2089x1764px; color fundus image:
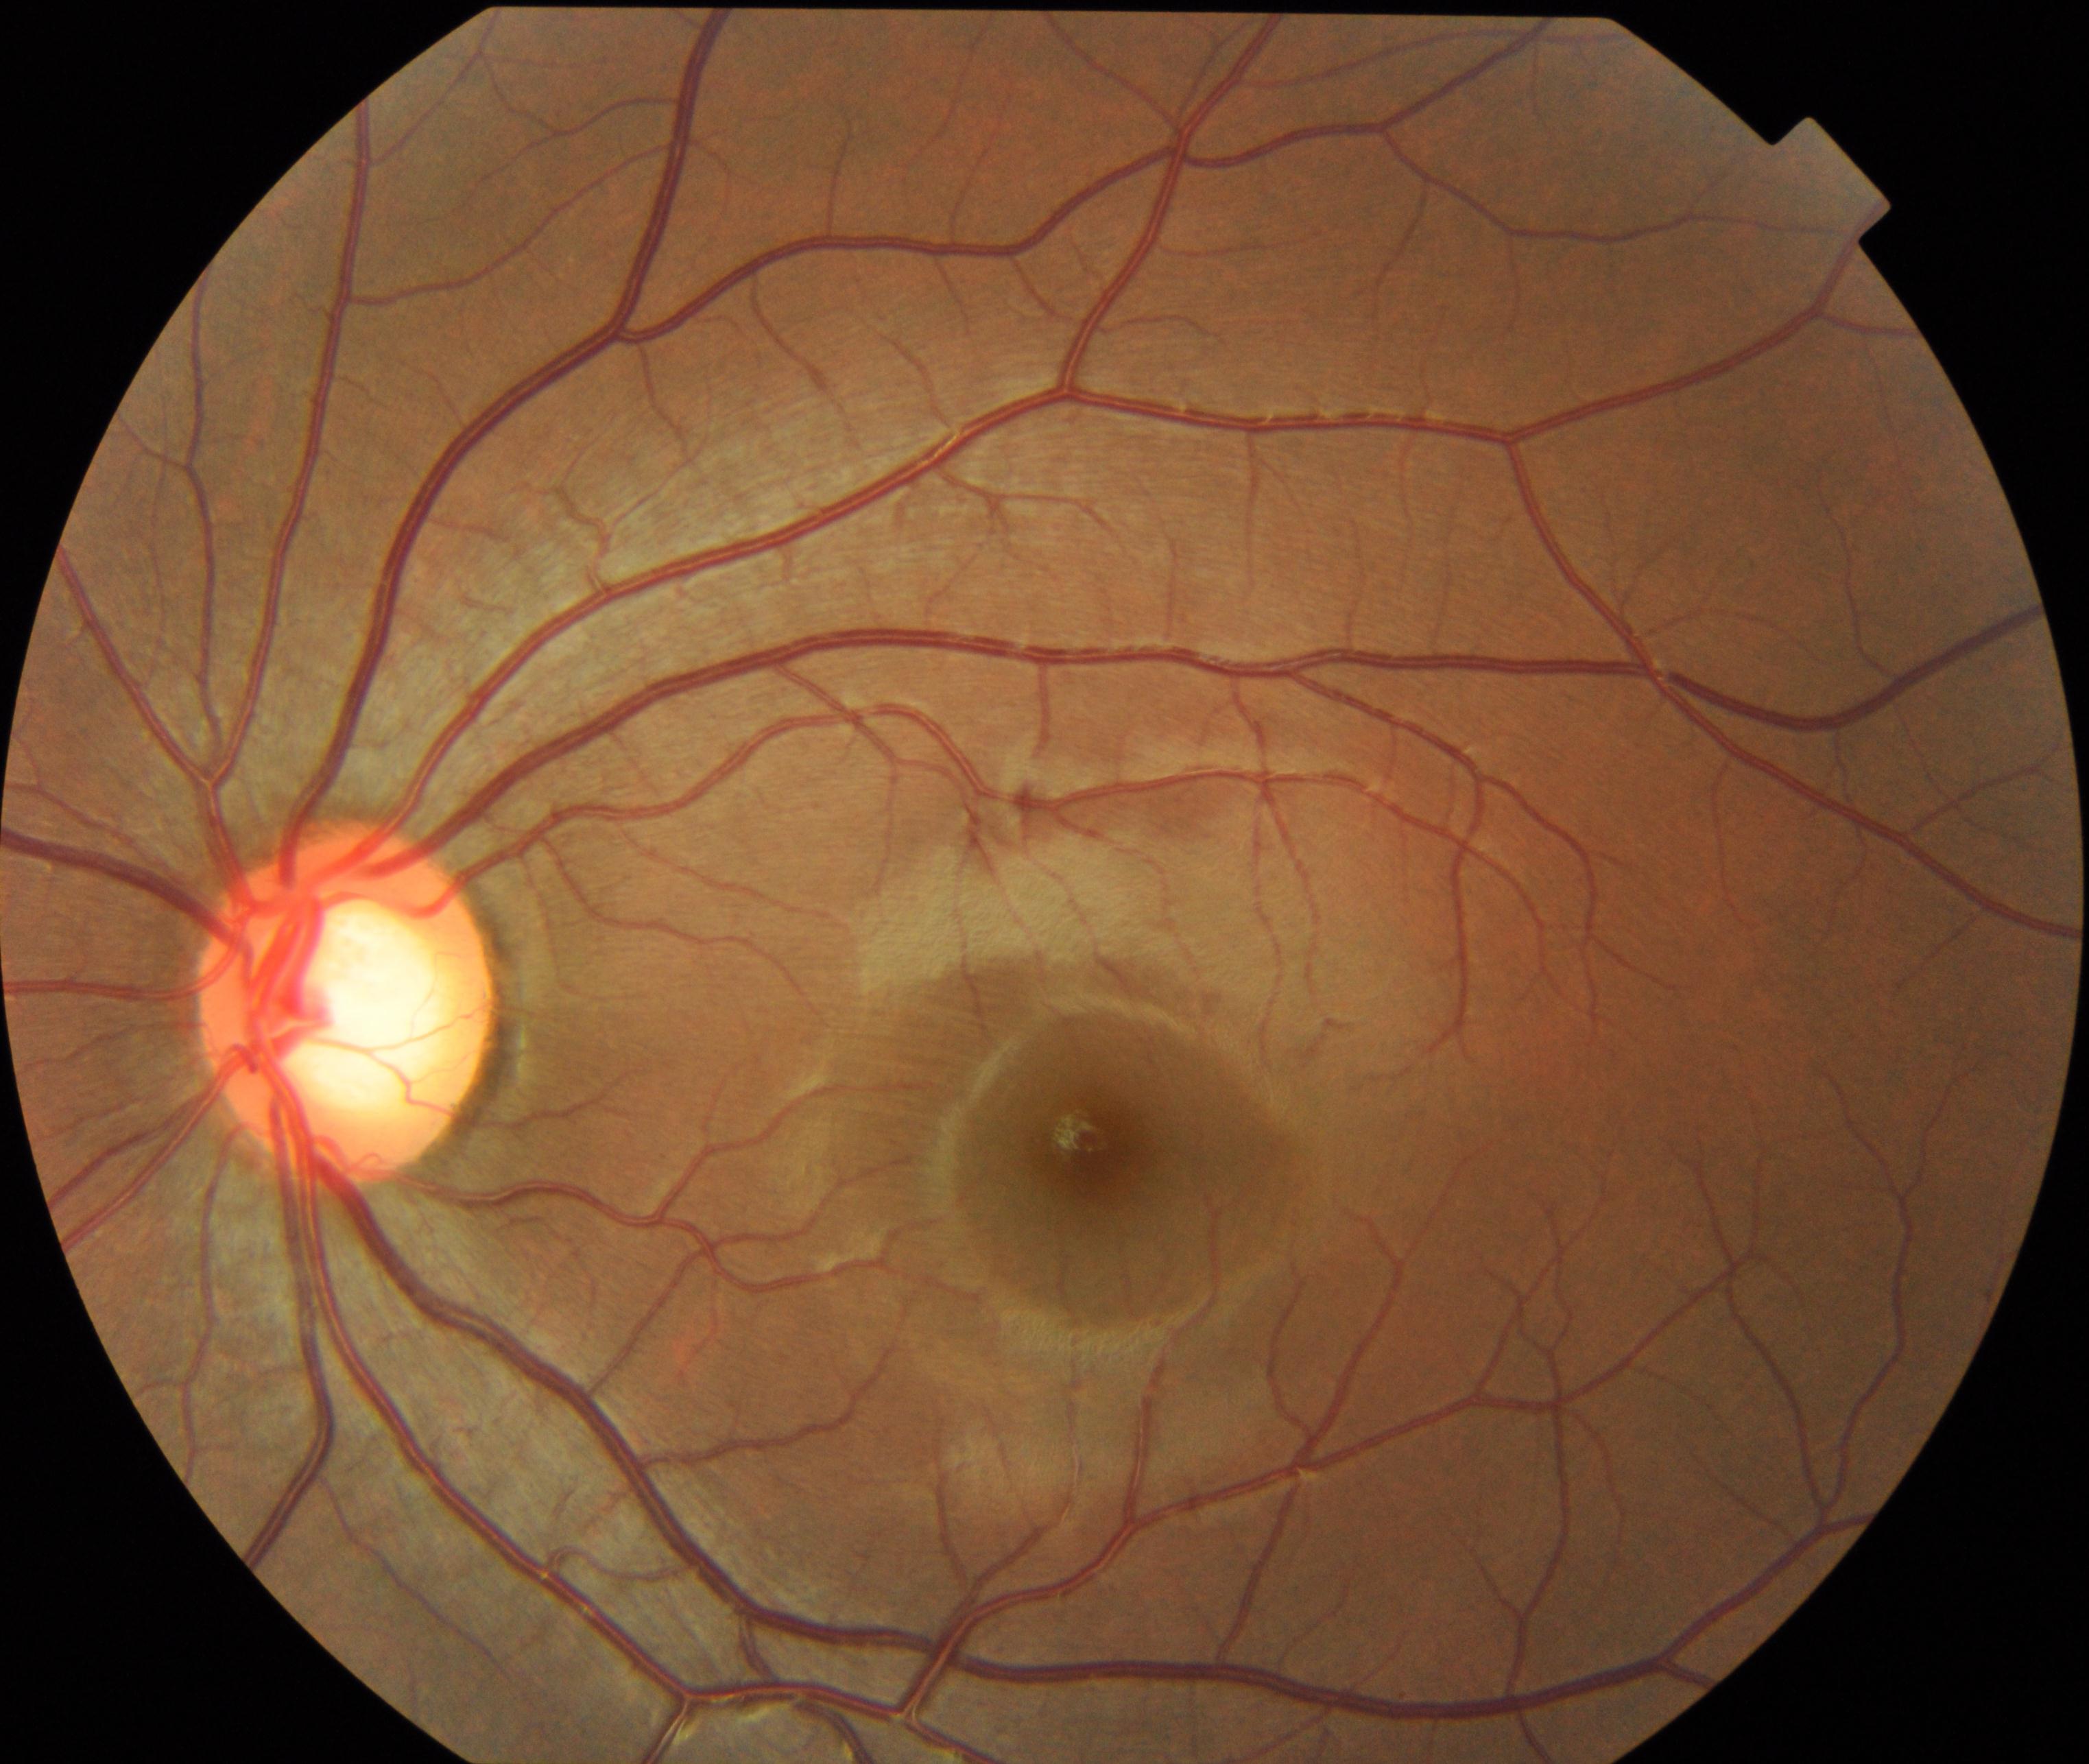 The image shows large optic cup.